848x848px · color fundus image — 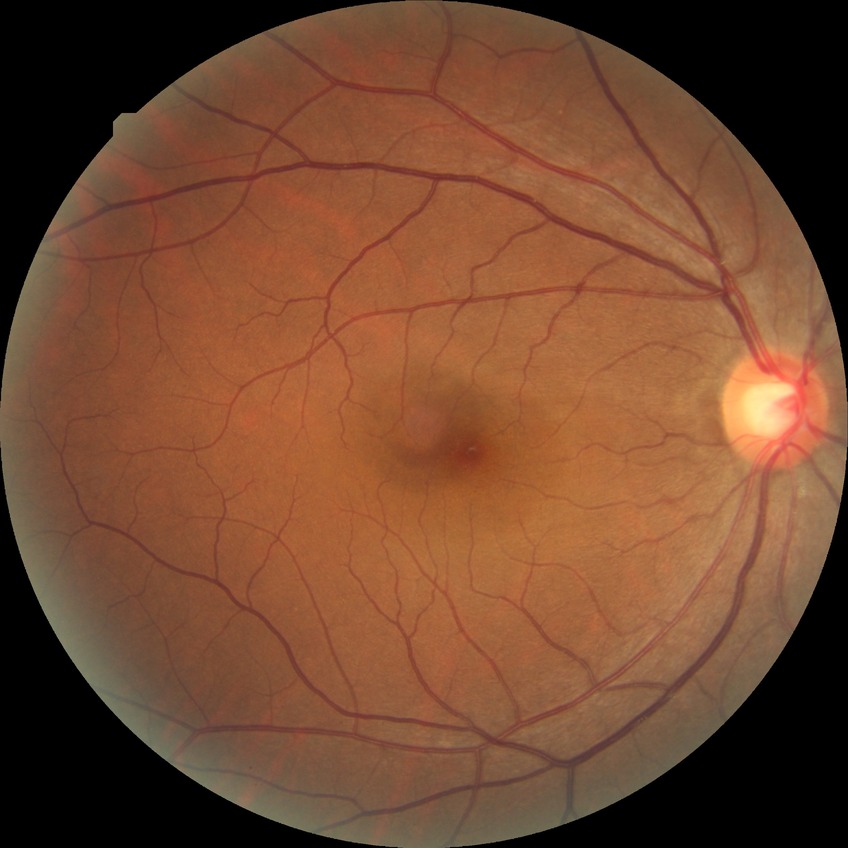

retinopathy stage@no diabetic retinopathy.